Cropped to the optic nerve head; retinal fundus photograph:
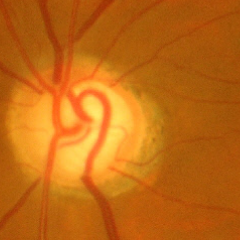

Glaucoma assessment = advanced glaucomatous optic neuropathy.